1659x2212
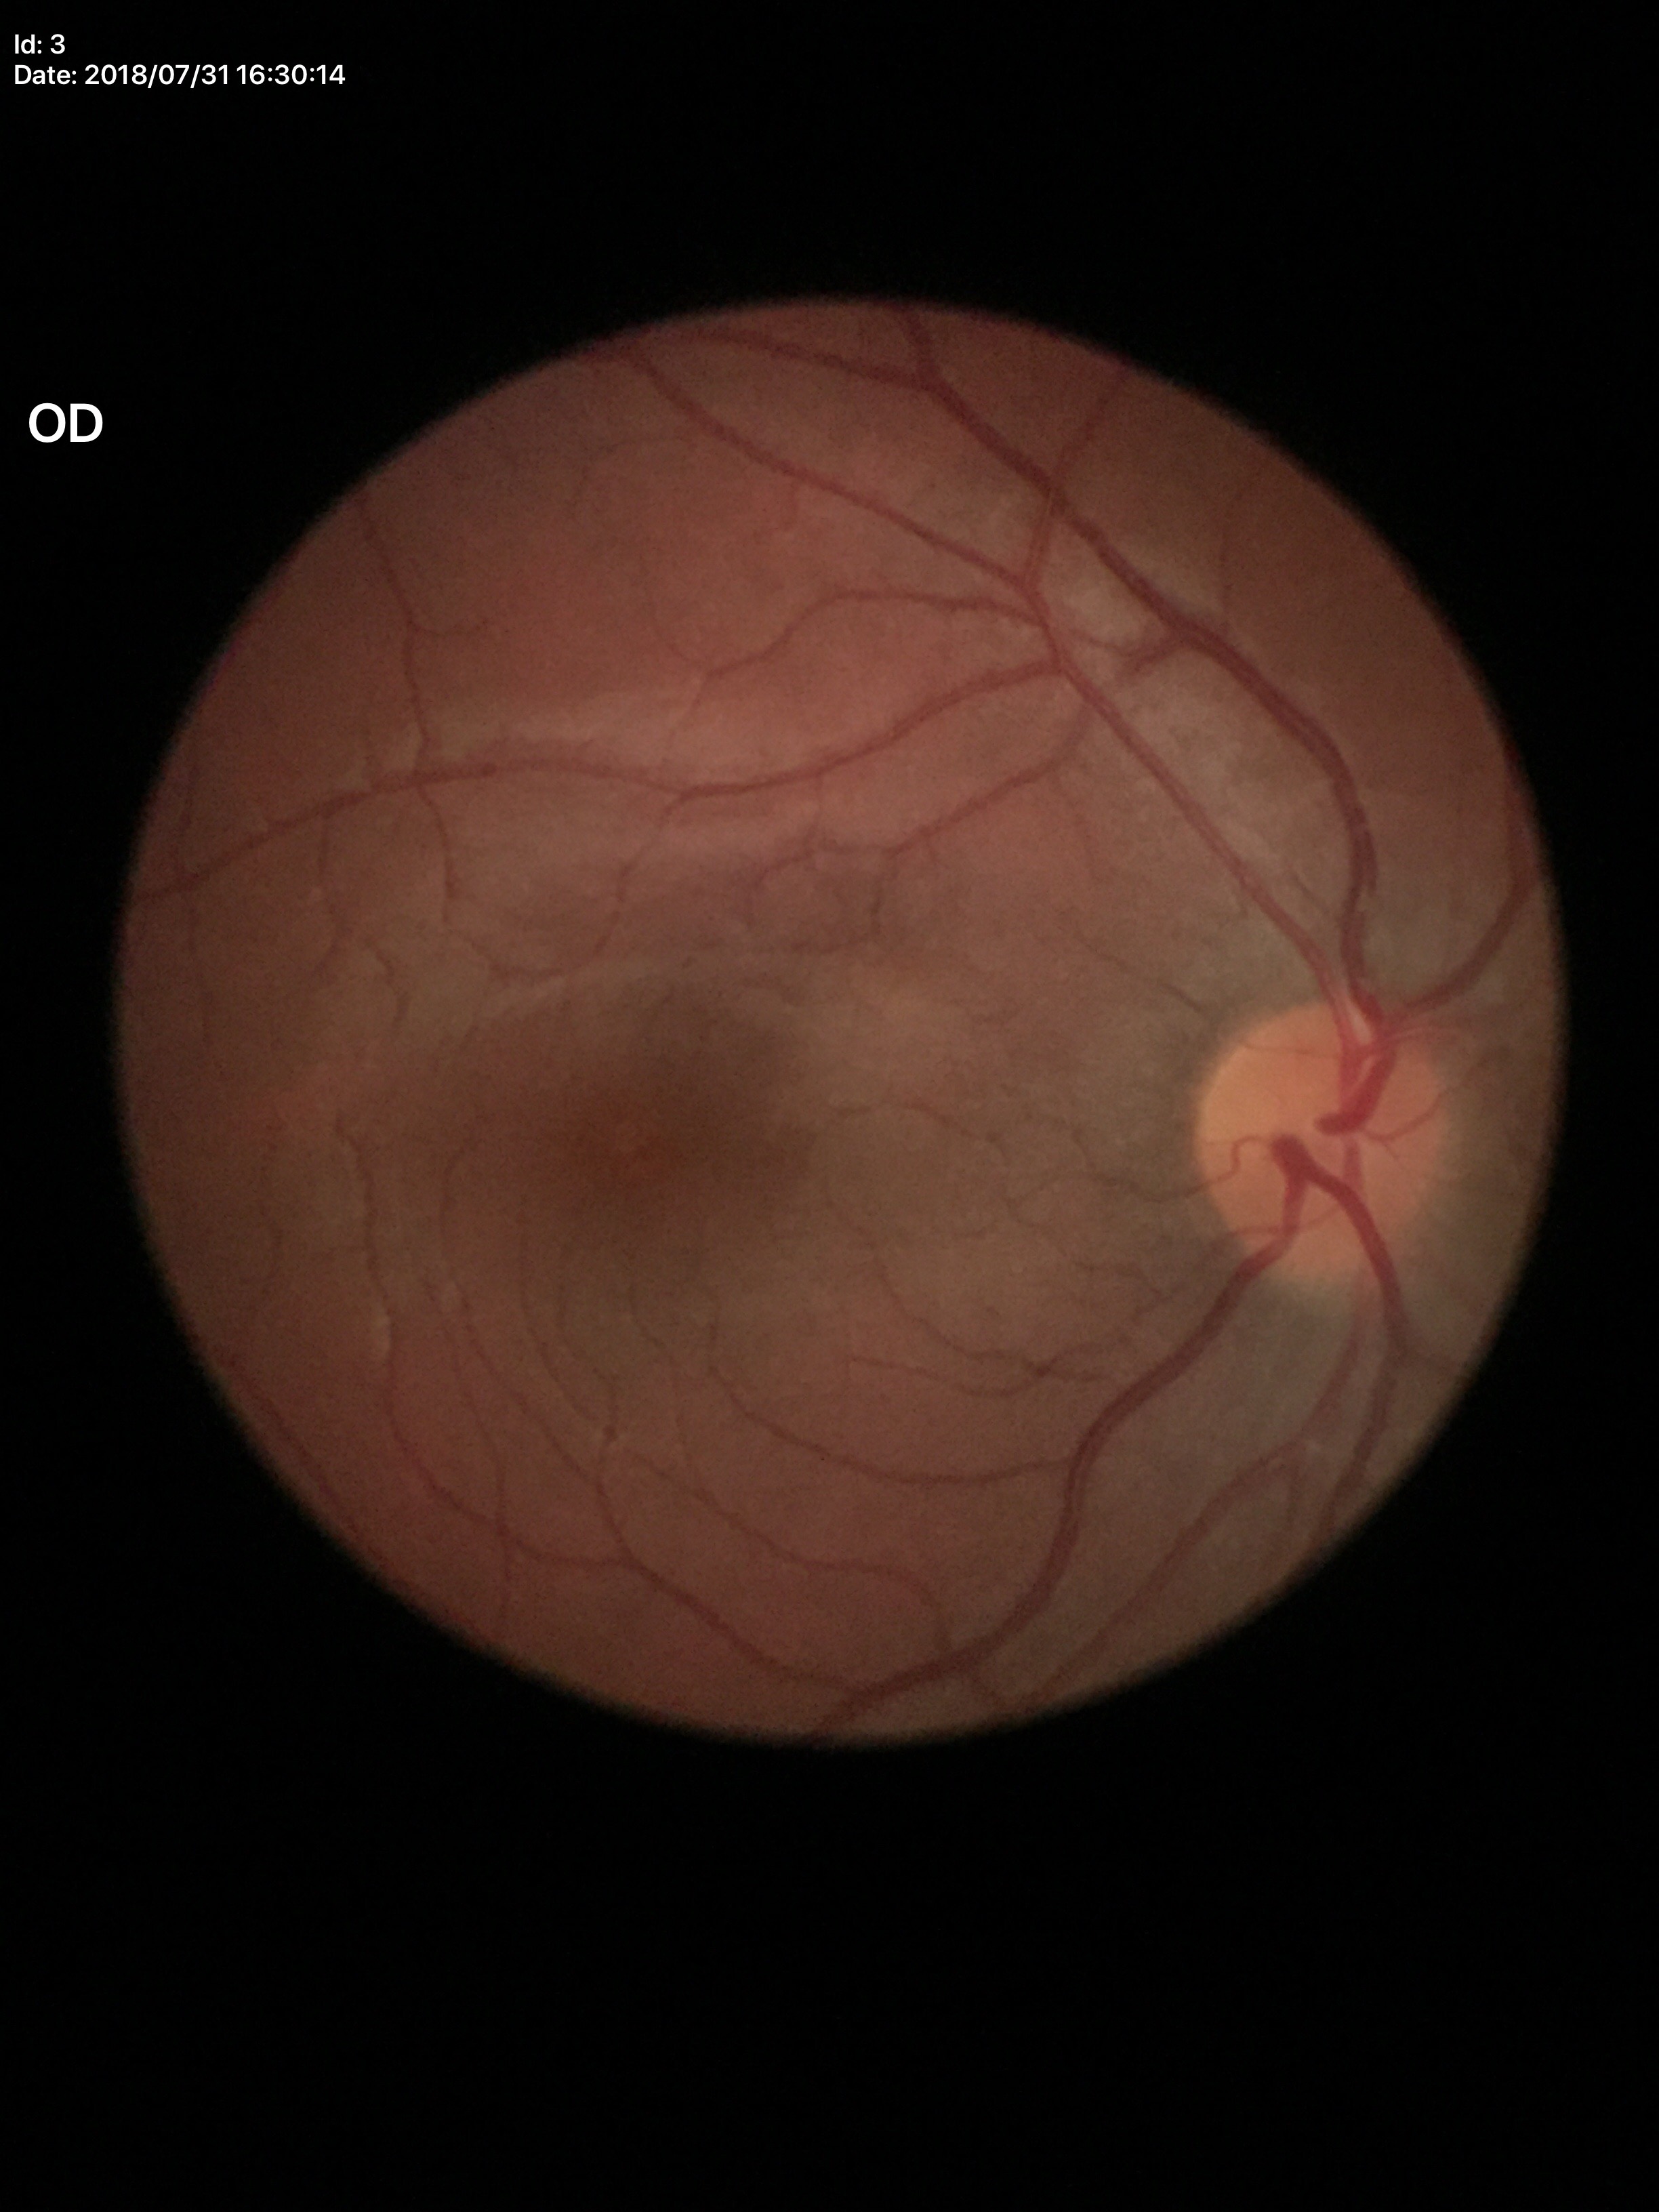
Glaucoma decision: no suspicious findings (unanimous normal call).
Vertical CDR of 0.39.
Horizontal cup-disc ratio is 0.41.